Ultra-widefield fundus photograph · 200° FOV: 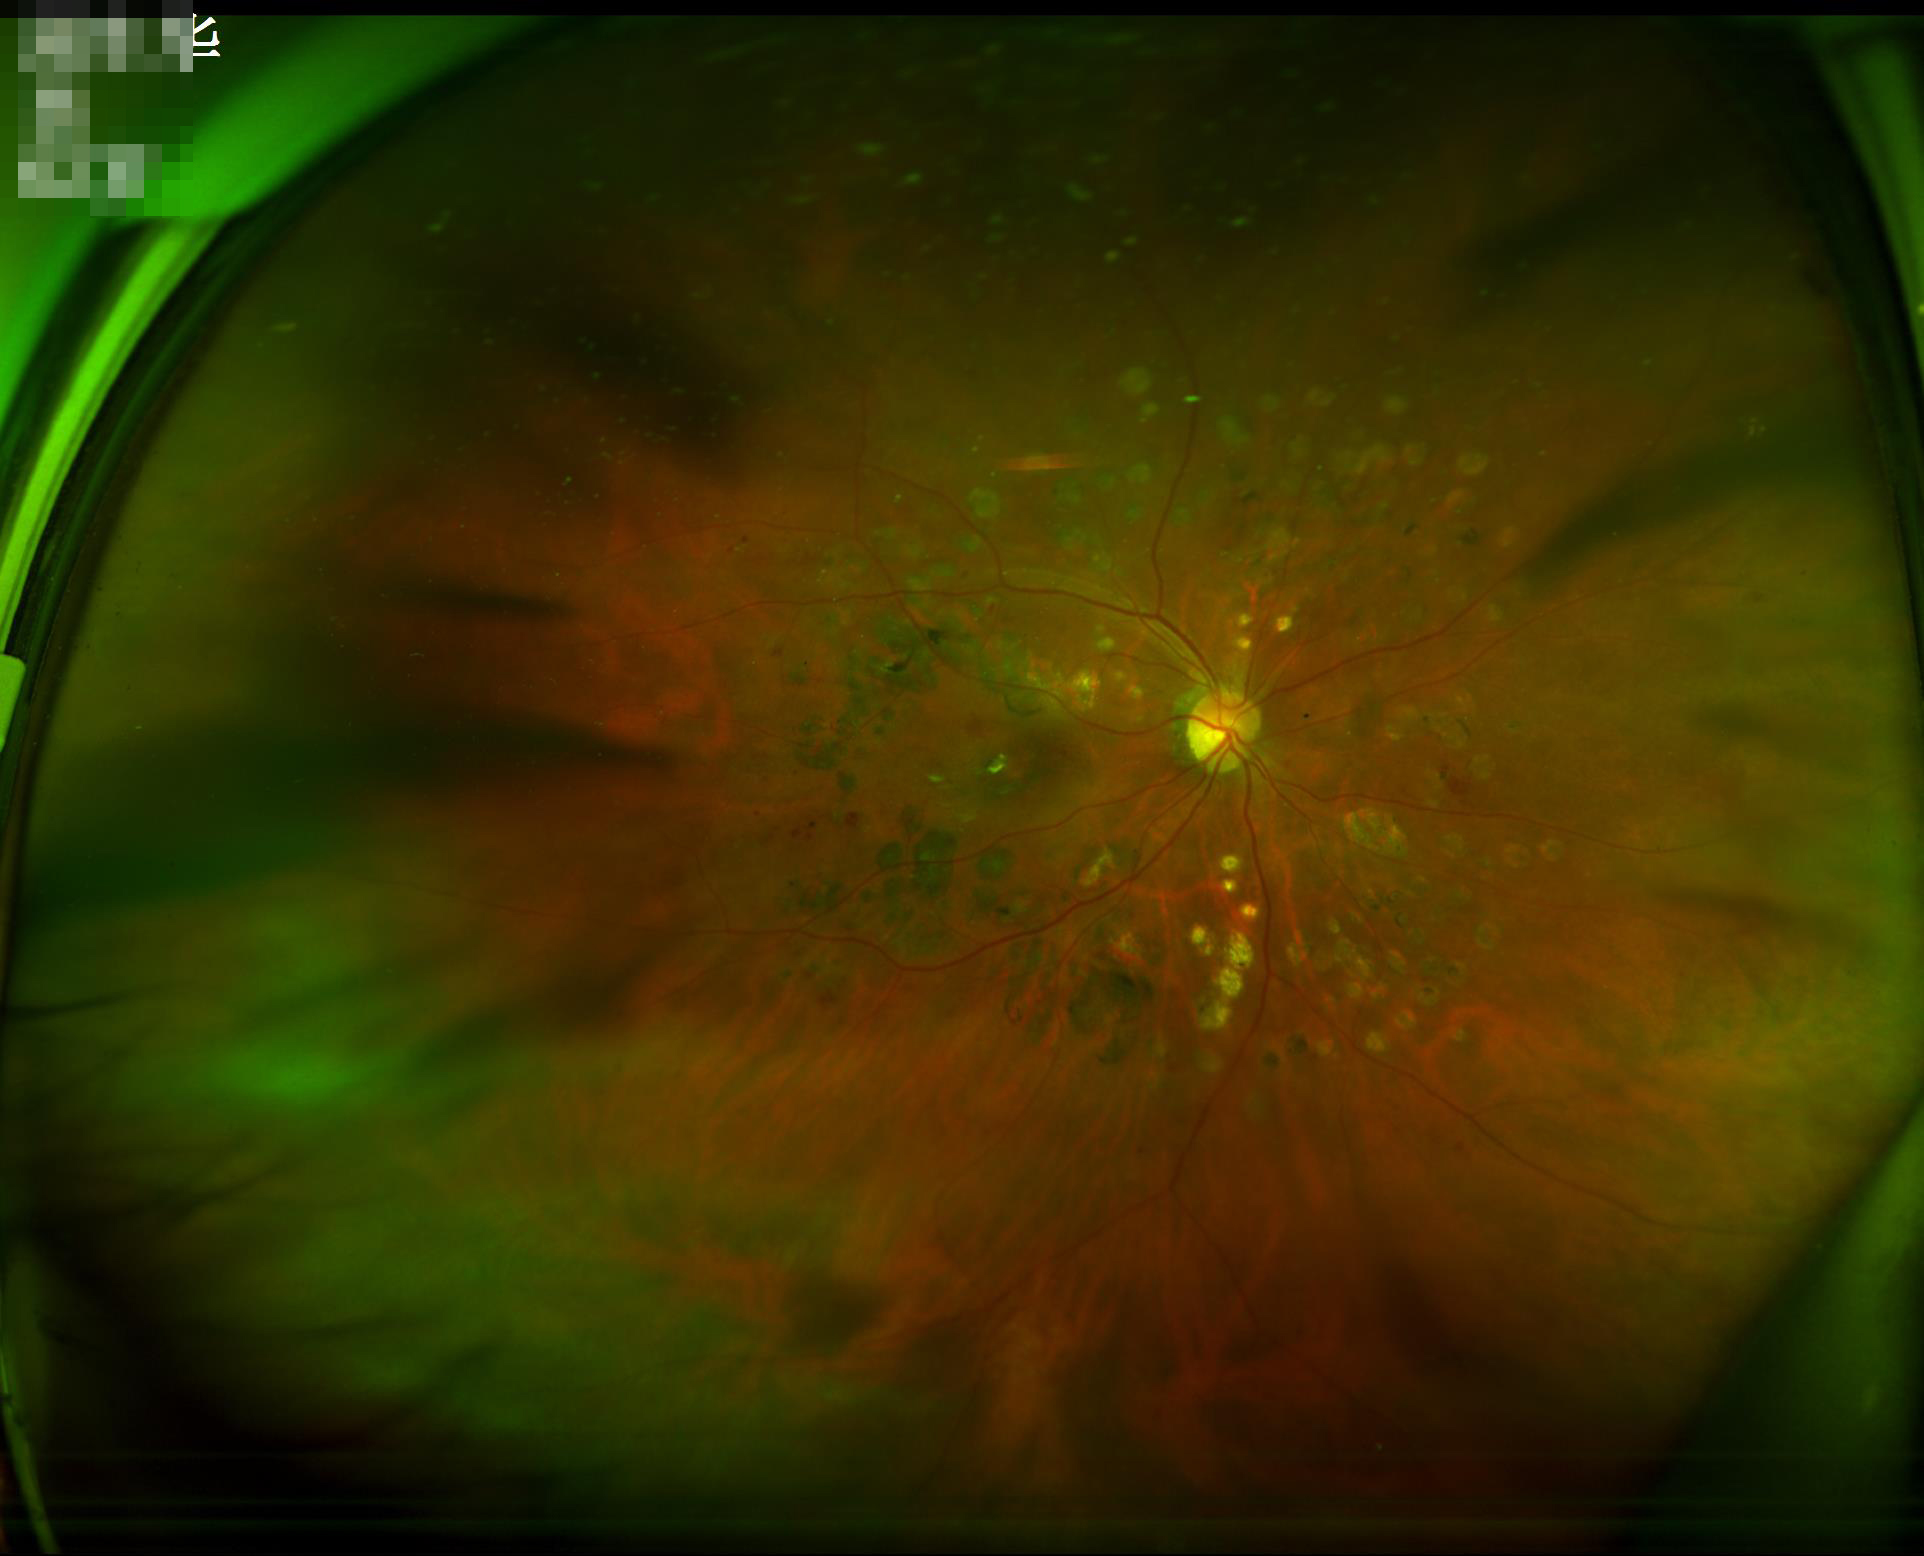 Image quality: overall: low; focus: out of focus; illumination/color: poor.